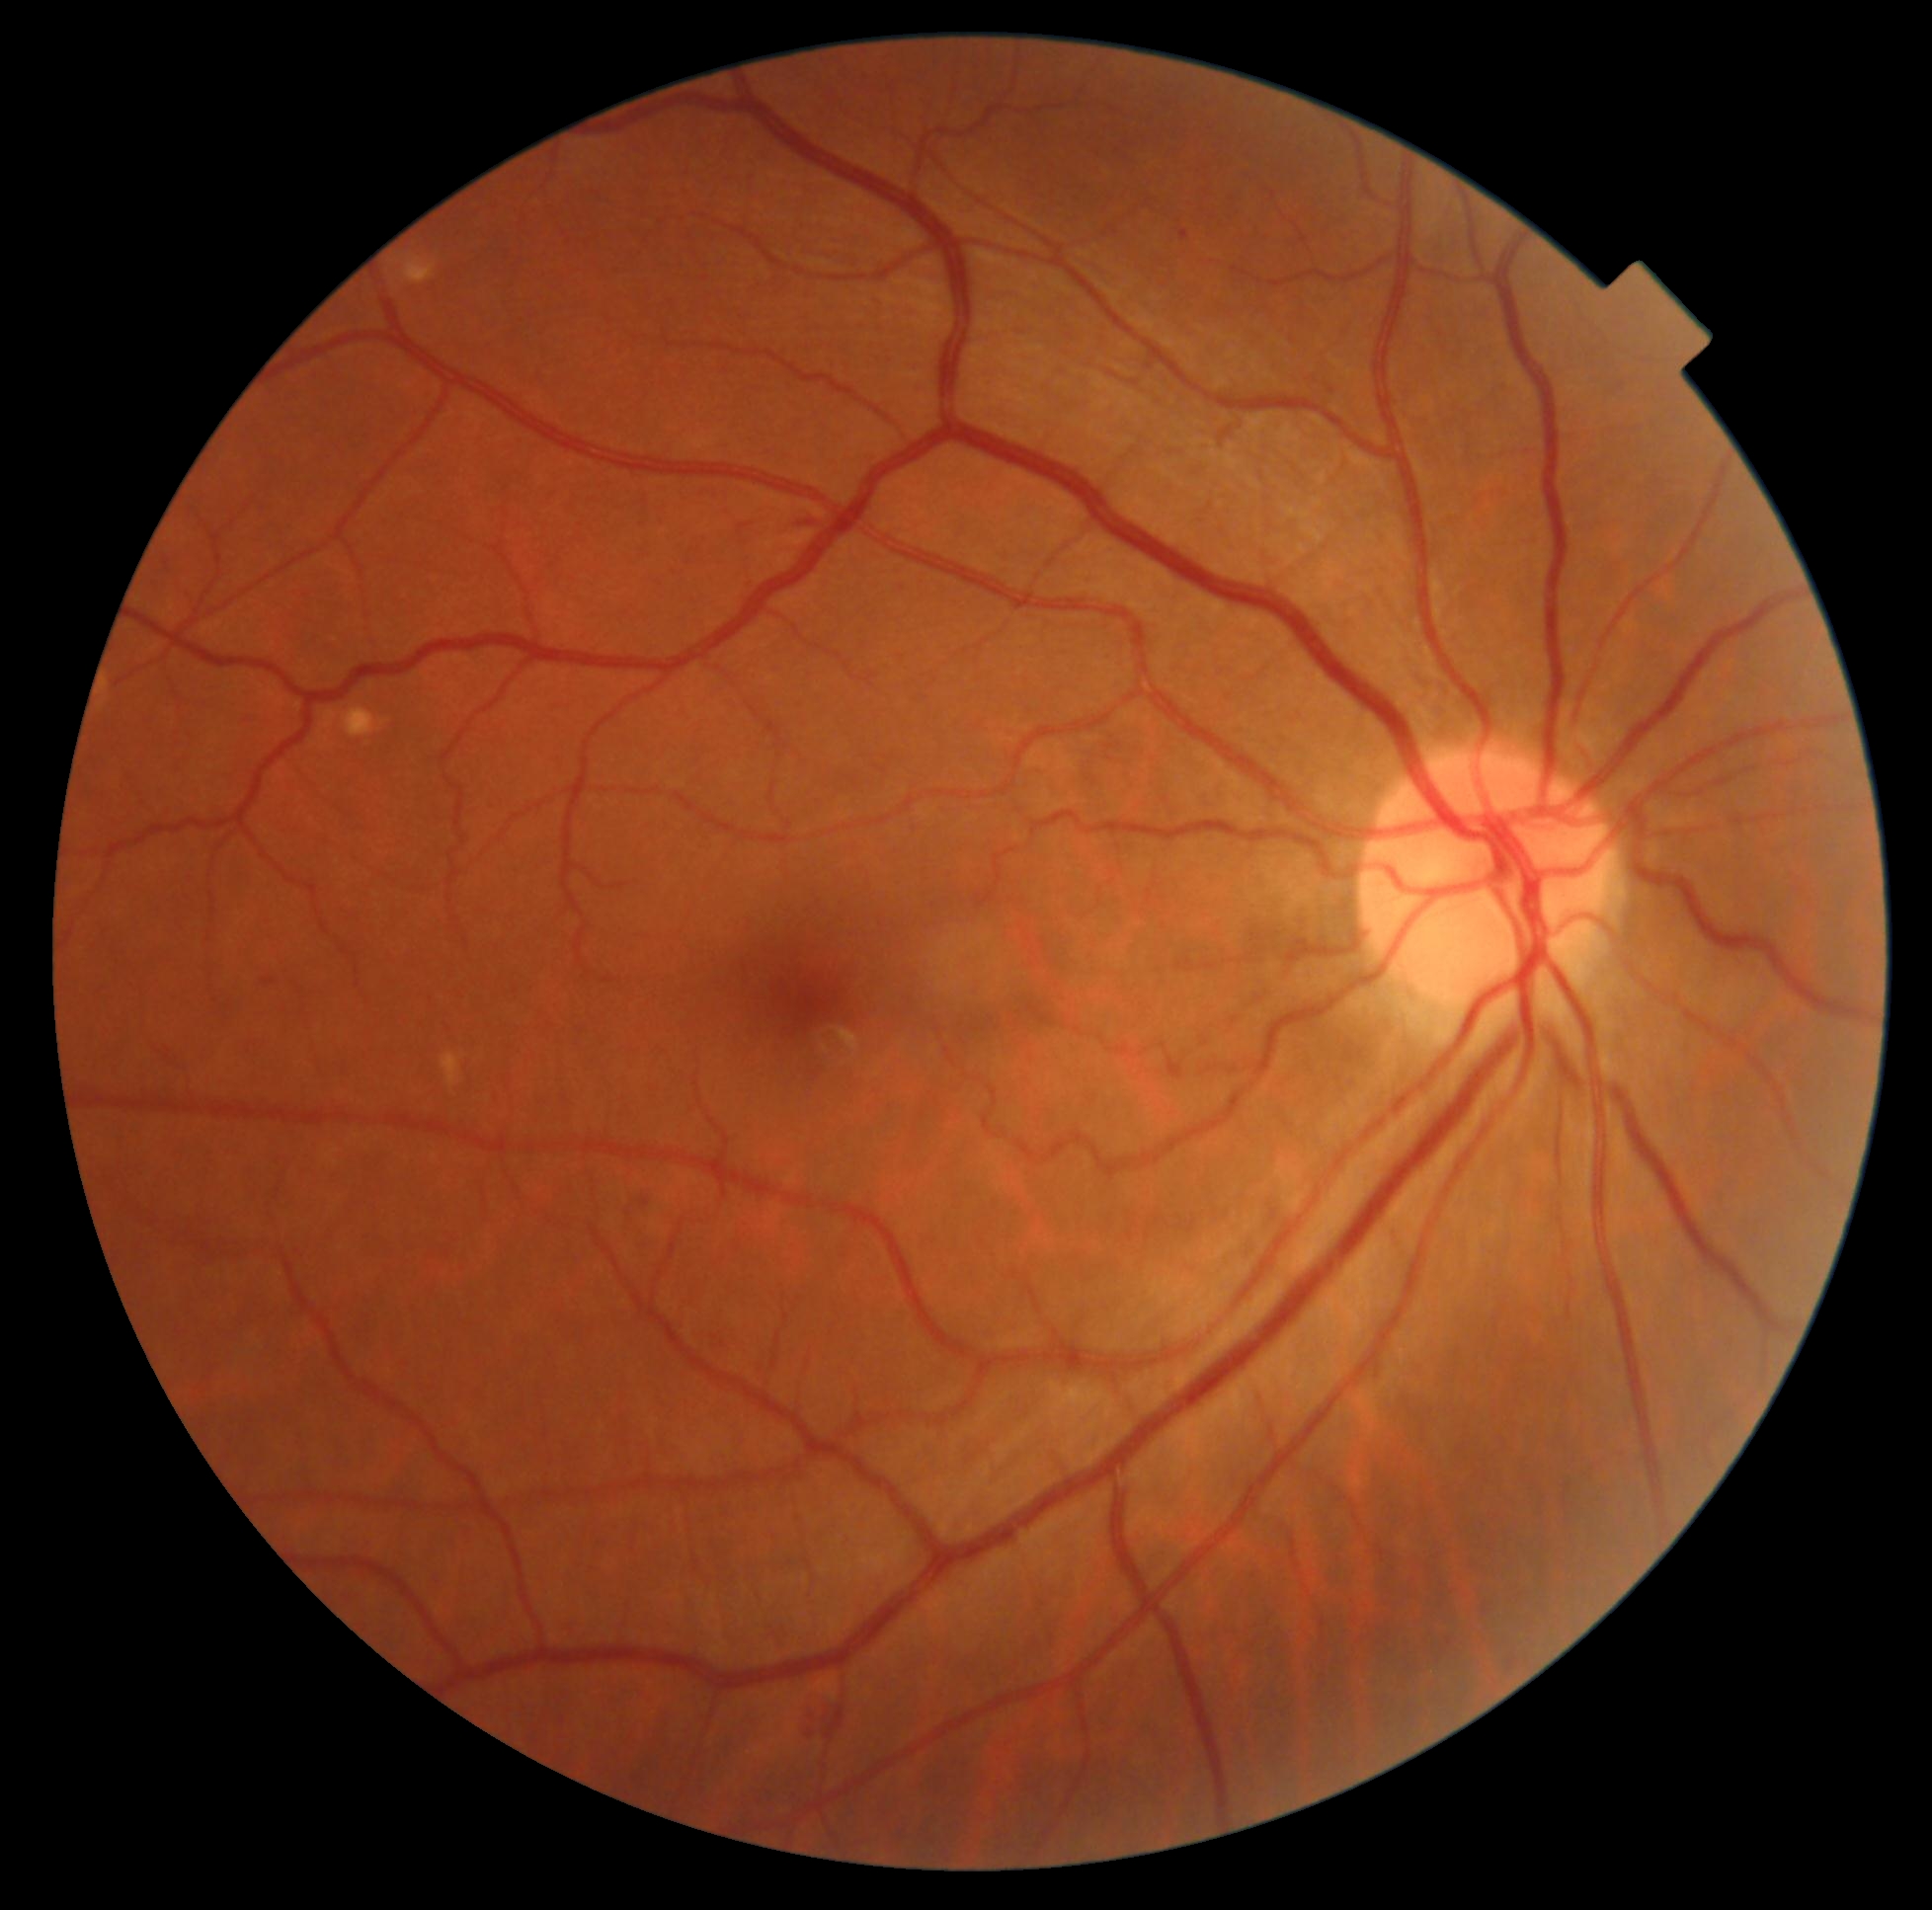

diabetic retinopathy (DR): 2/4.